Without pupil dilation; fundus photo; image size 848x848
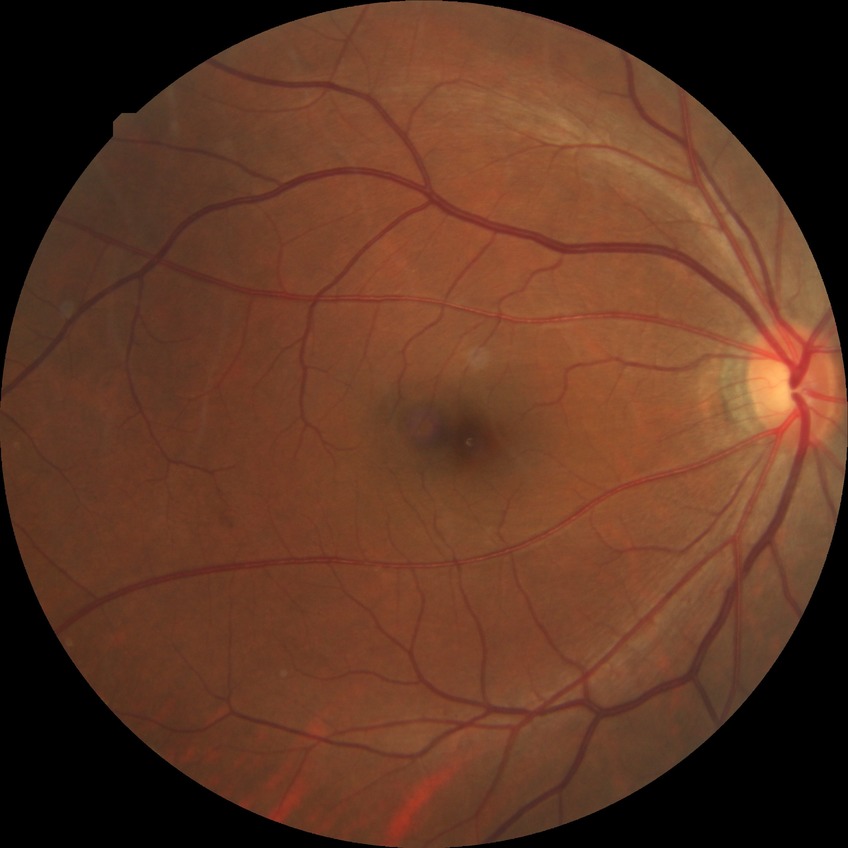

Diabetic retinopathy (DR) is NDR (no diabetic retinopathy).